45° field of view
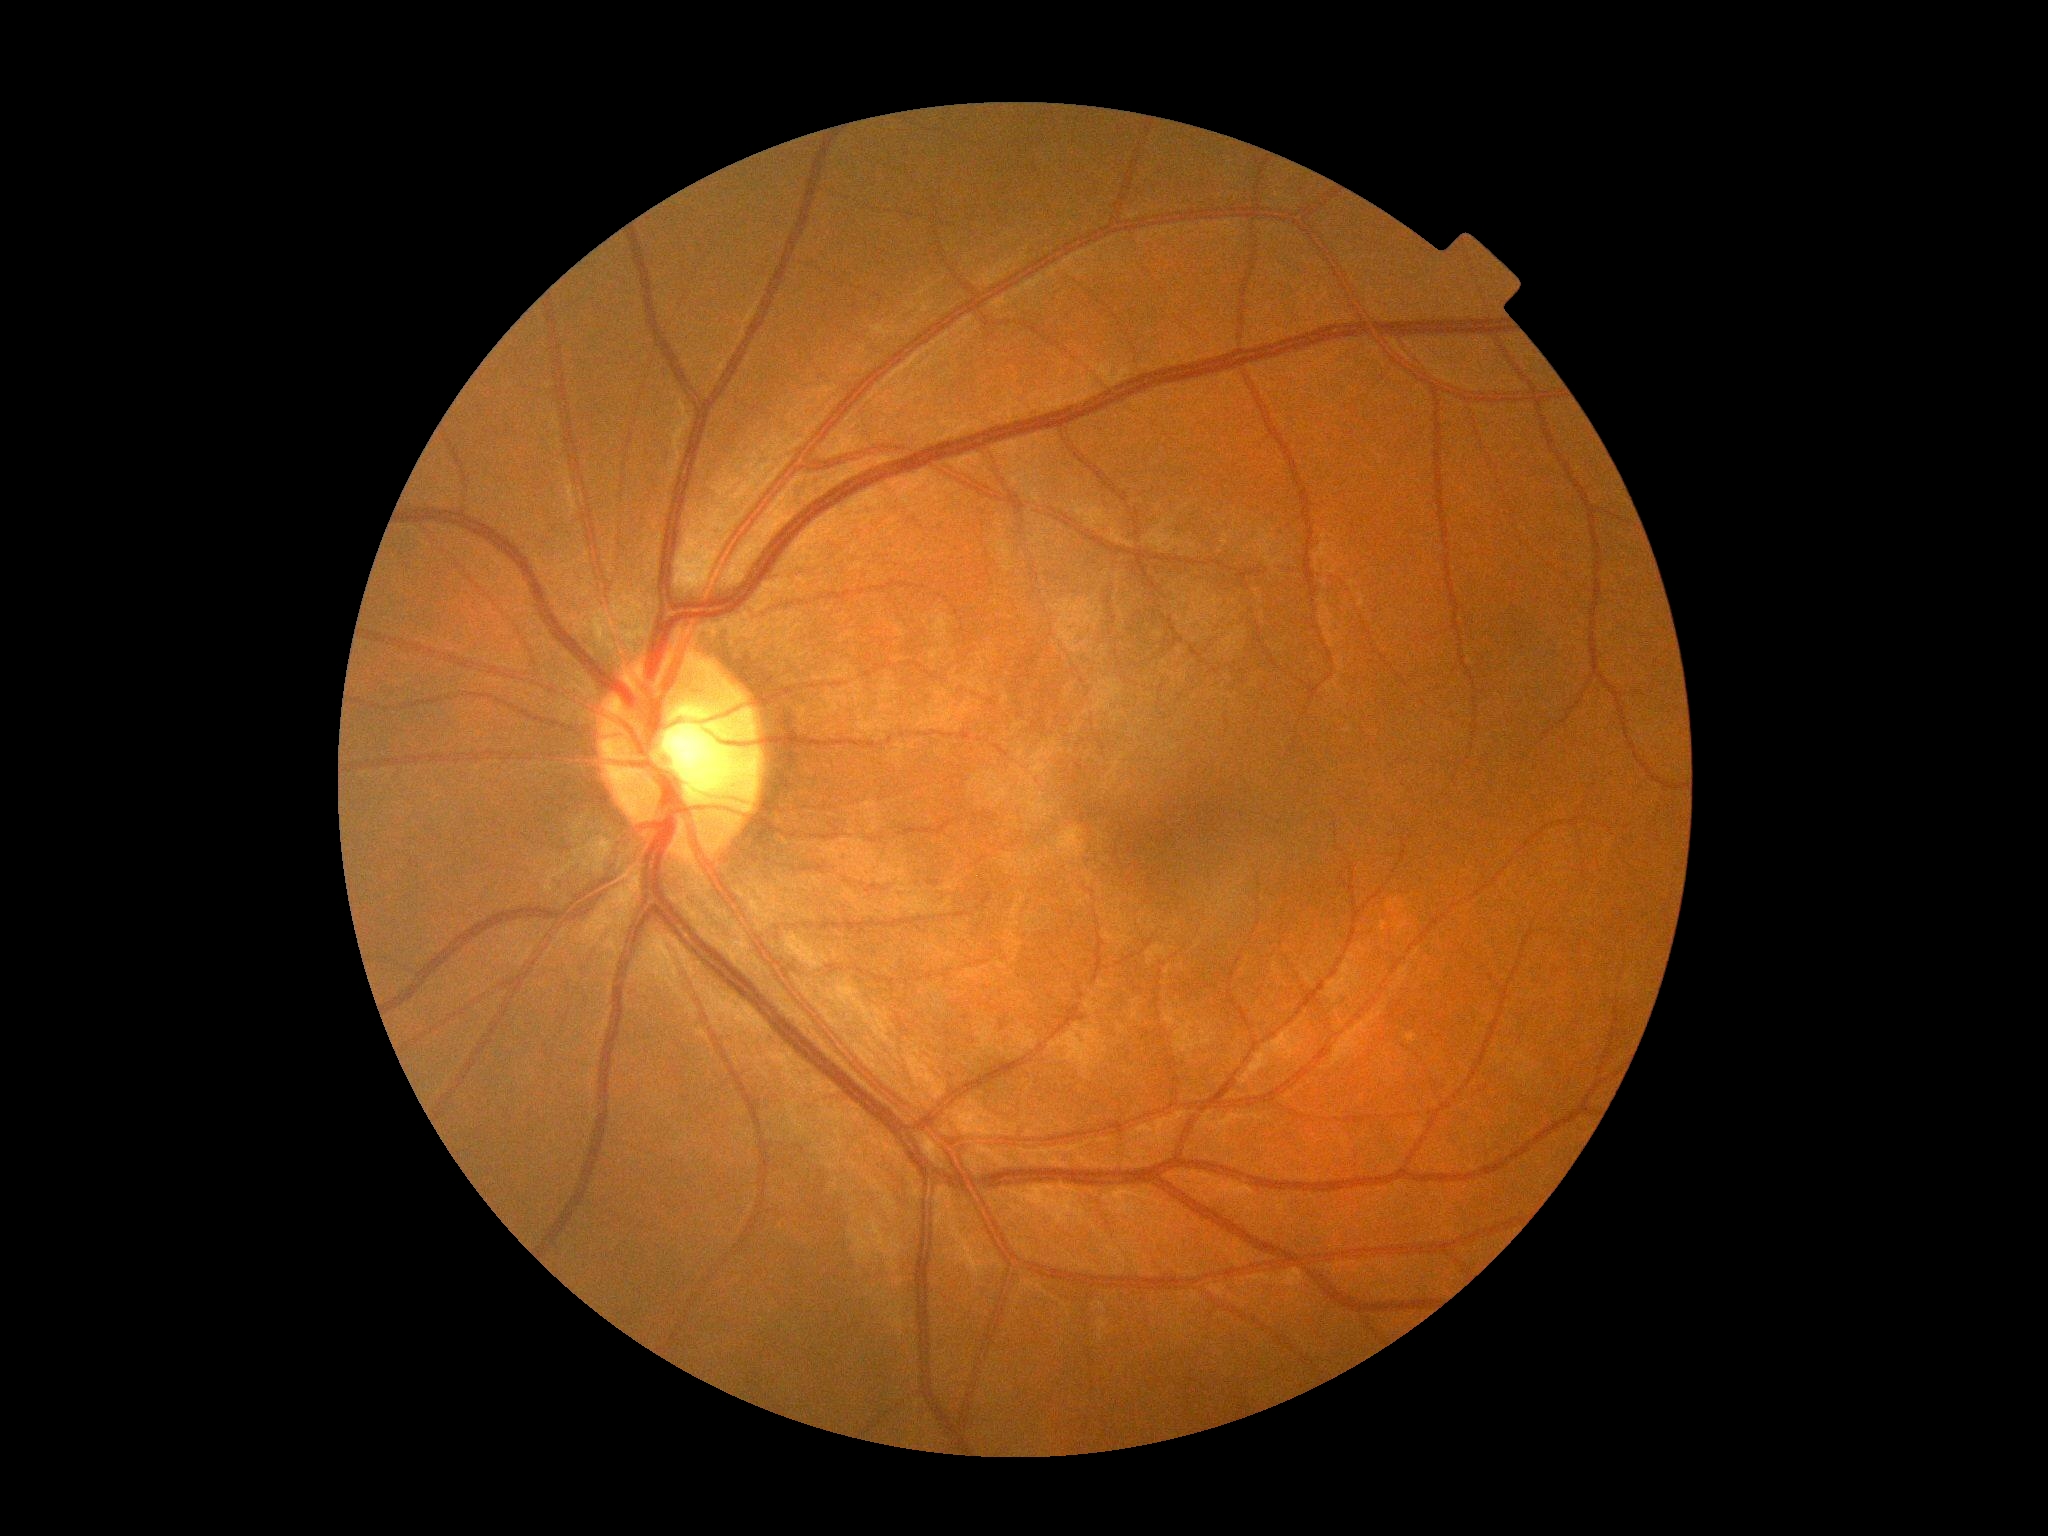 DR stage: 0/4.